45° FOV.
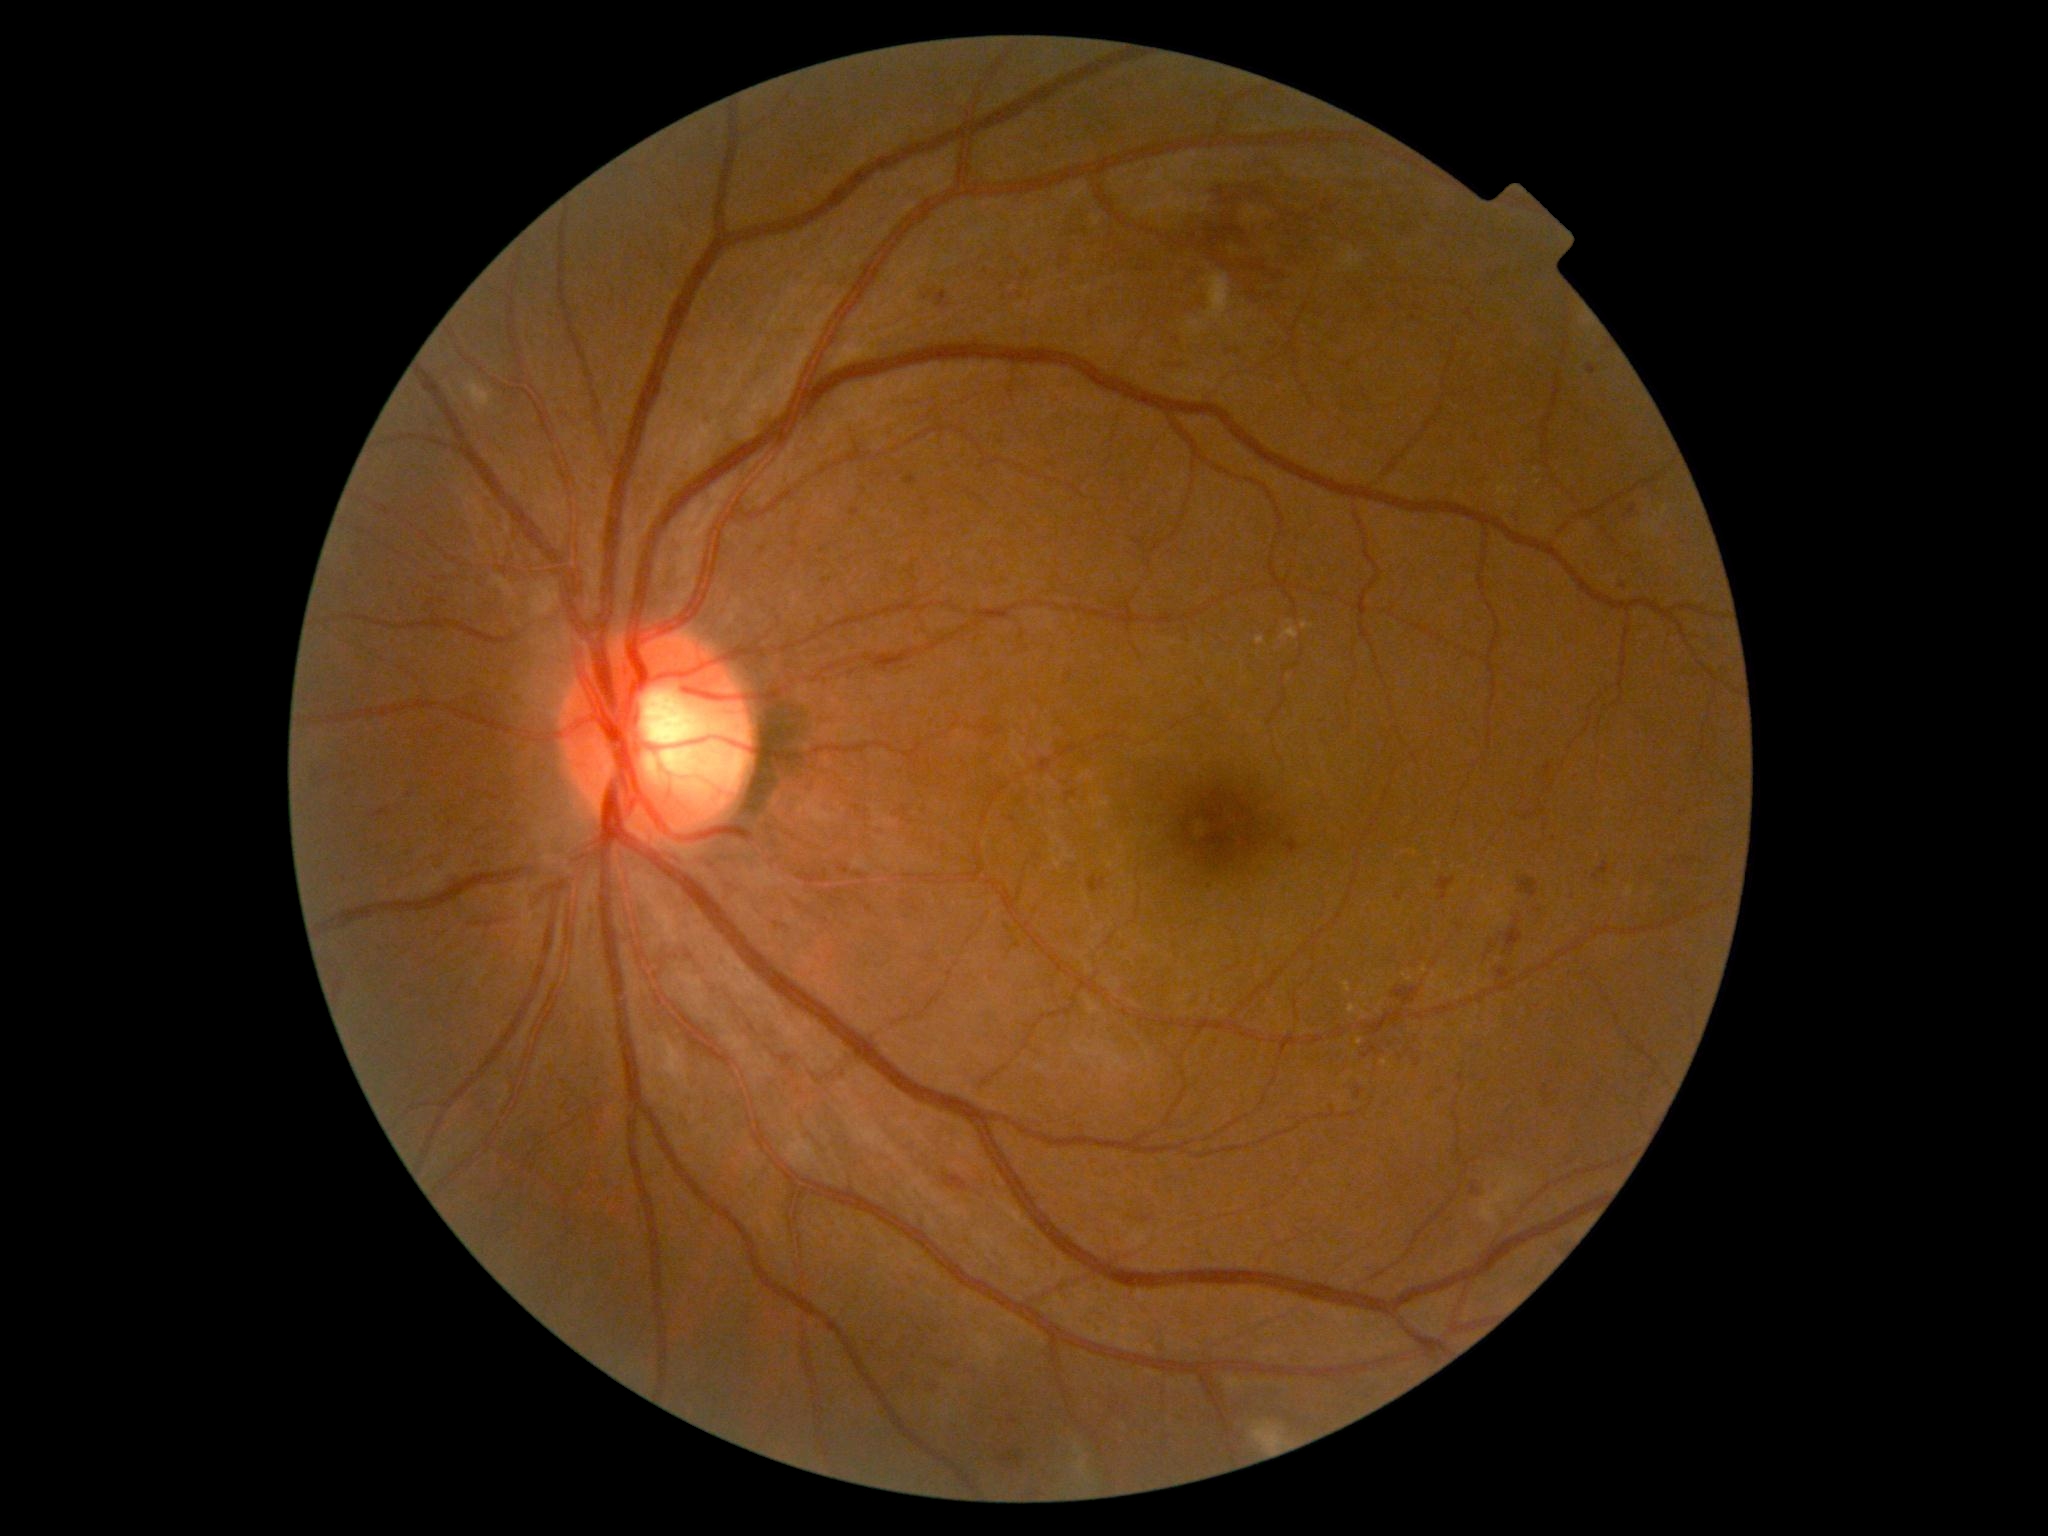 Diabetic retinopathy (DR): 2 — more than just microaneurysms but less than severe NPDR.
Microaneurysms (MAs) are present, including at rect(857, 873, 867, 880); rect(1009, 1414, 1018, 1424); rect(1415, 1059, 1422, 1067); rect(793, 542, 800, 550); rect(1588, 365, 1597, 375); rect(492, 797, 502, 801); rect(850, 508, 860, 518).
Additional small MAs near Point(410, 795); Point(825, 581); Point(452, 823); Point(1401, 1057); Point(763, 551); Point(864, 492); Point(916, 909); Point(1624, 587).
Hemorrhages (HEs) are present, including at rect(1285, 838, 1299, 854); rect(1060, 257, 1069, 274); rect(1392, 987, 1419, 1004); rect(1481, 933, 1492, 970); rect(1177, 267, 1199, 315); rect(936, 291, 950, 309); rect(1089, 876, 1106, 893); rect(1472, 1179, 1488, 1196); rect(373, 808, 391, 818); rect(1289, 187, 1369, 244); rect(335, 981, 343, 993); rect(1630, 505, 1638, 515); rect(1505, 928, 1524, 953); rect(469, 918, 502, 929); rect(1518, 877, 1539, 898); rect(1498, 967, 1509, 980); rect(1066, 791, 1077, 803).
Additional small HEs near Point(1021, 295); Point(335, 997).